Fundus photo — 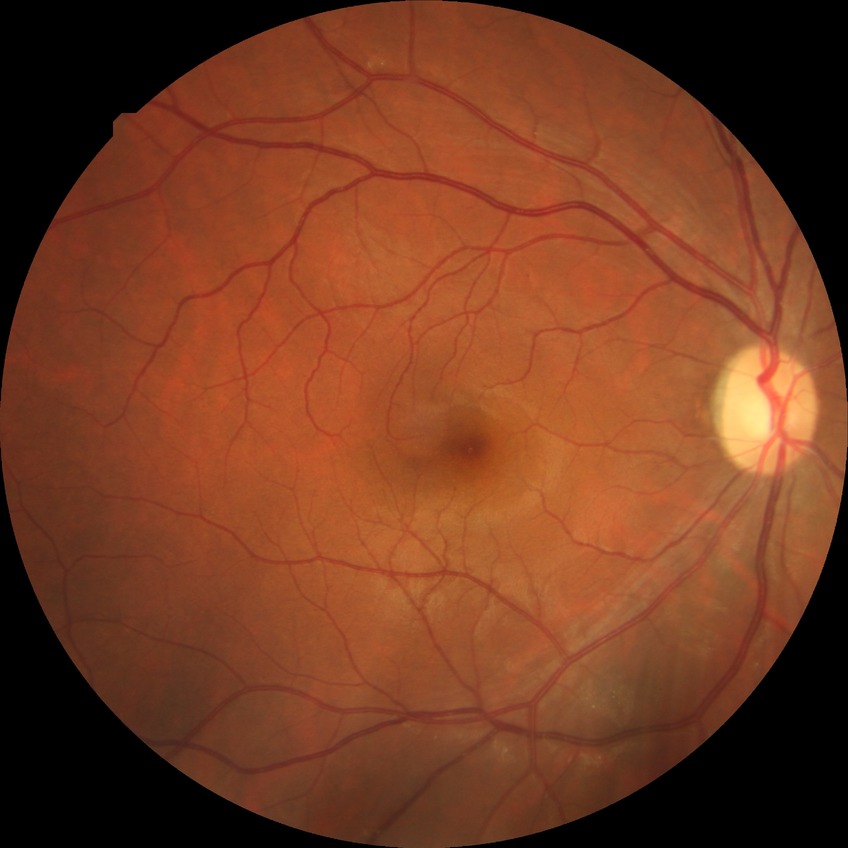 Diabetic retinopathy (DR): no diabetic retinopathy (NDR).